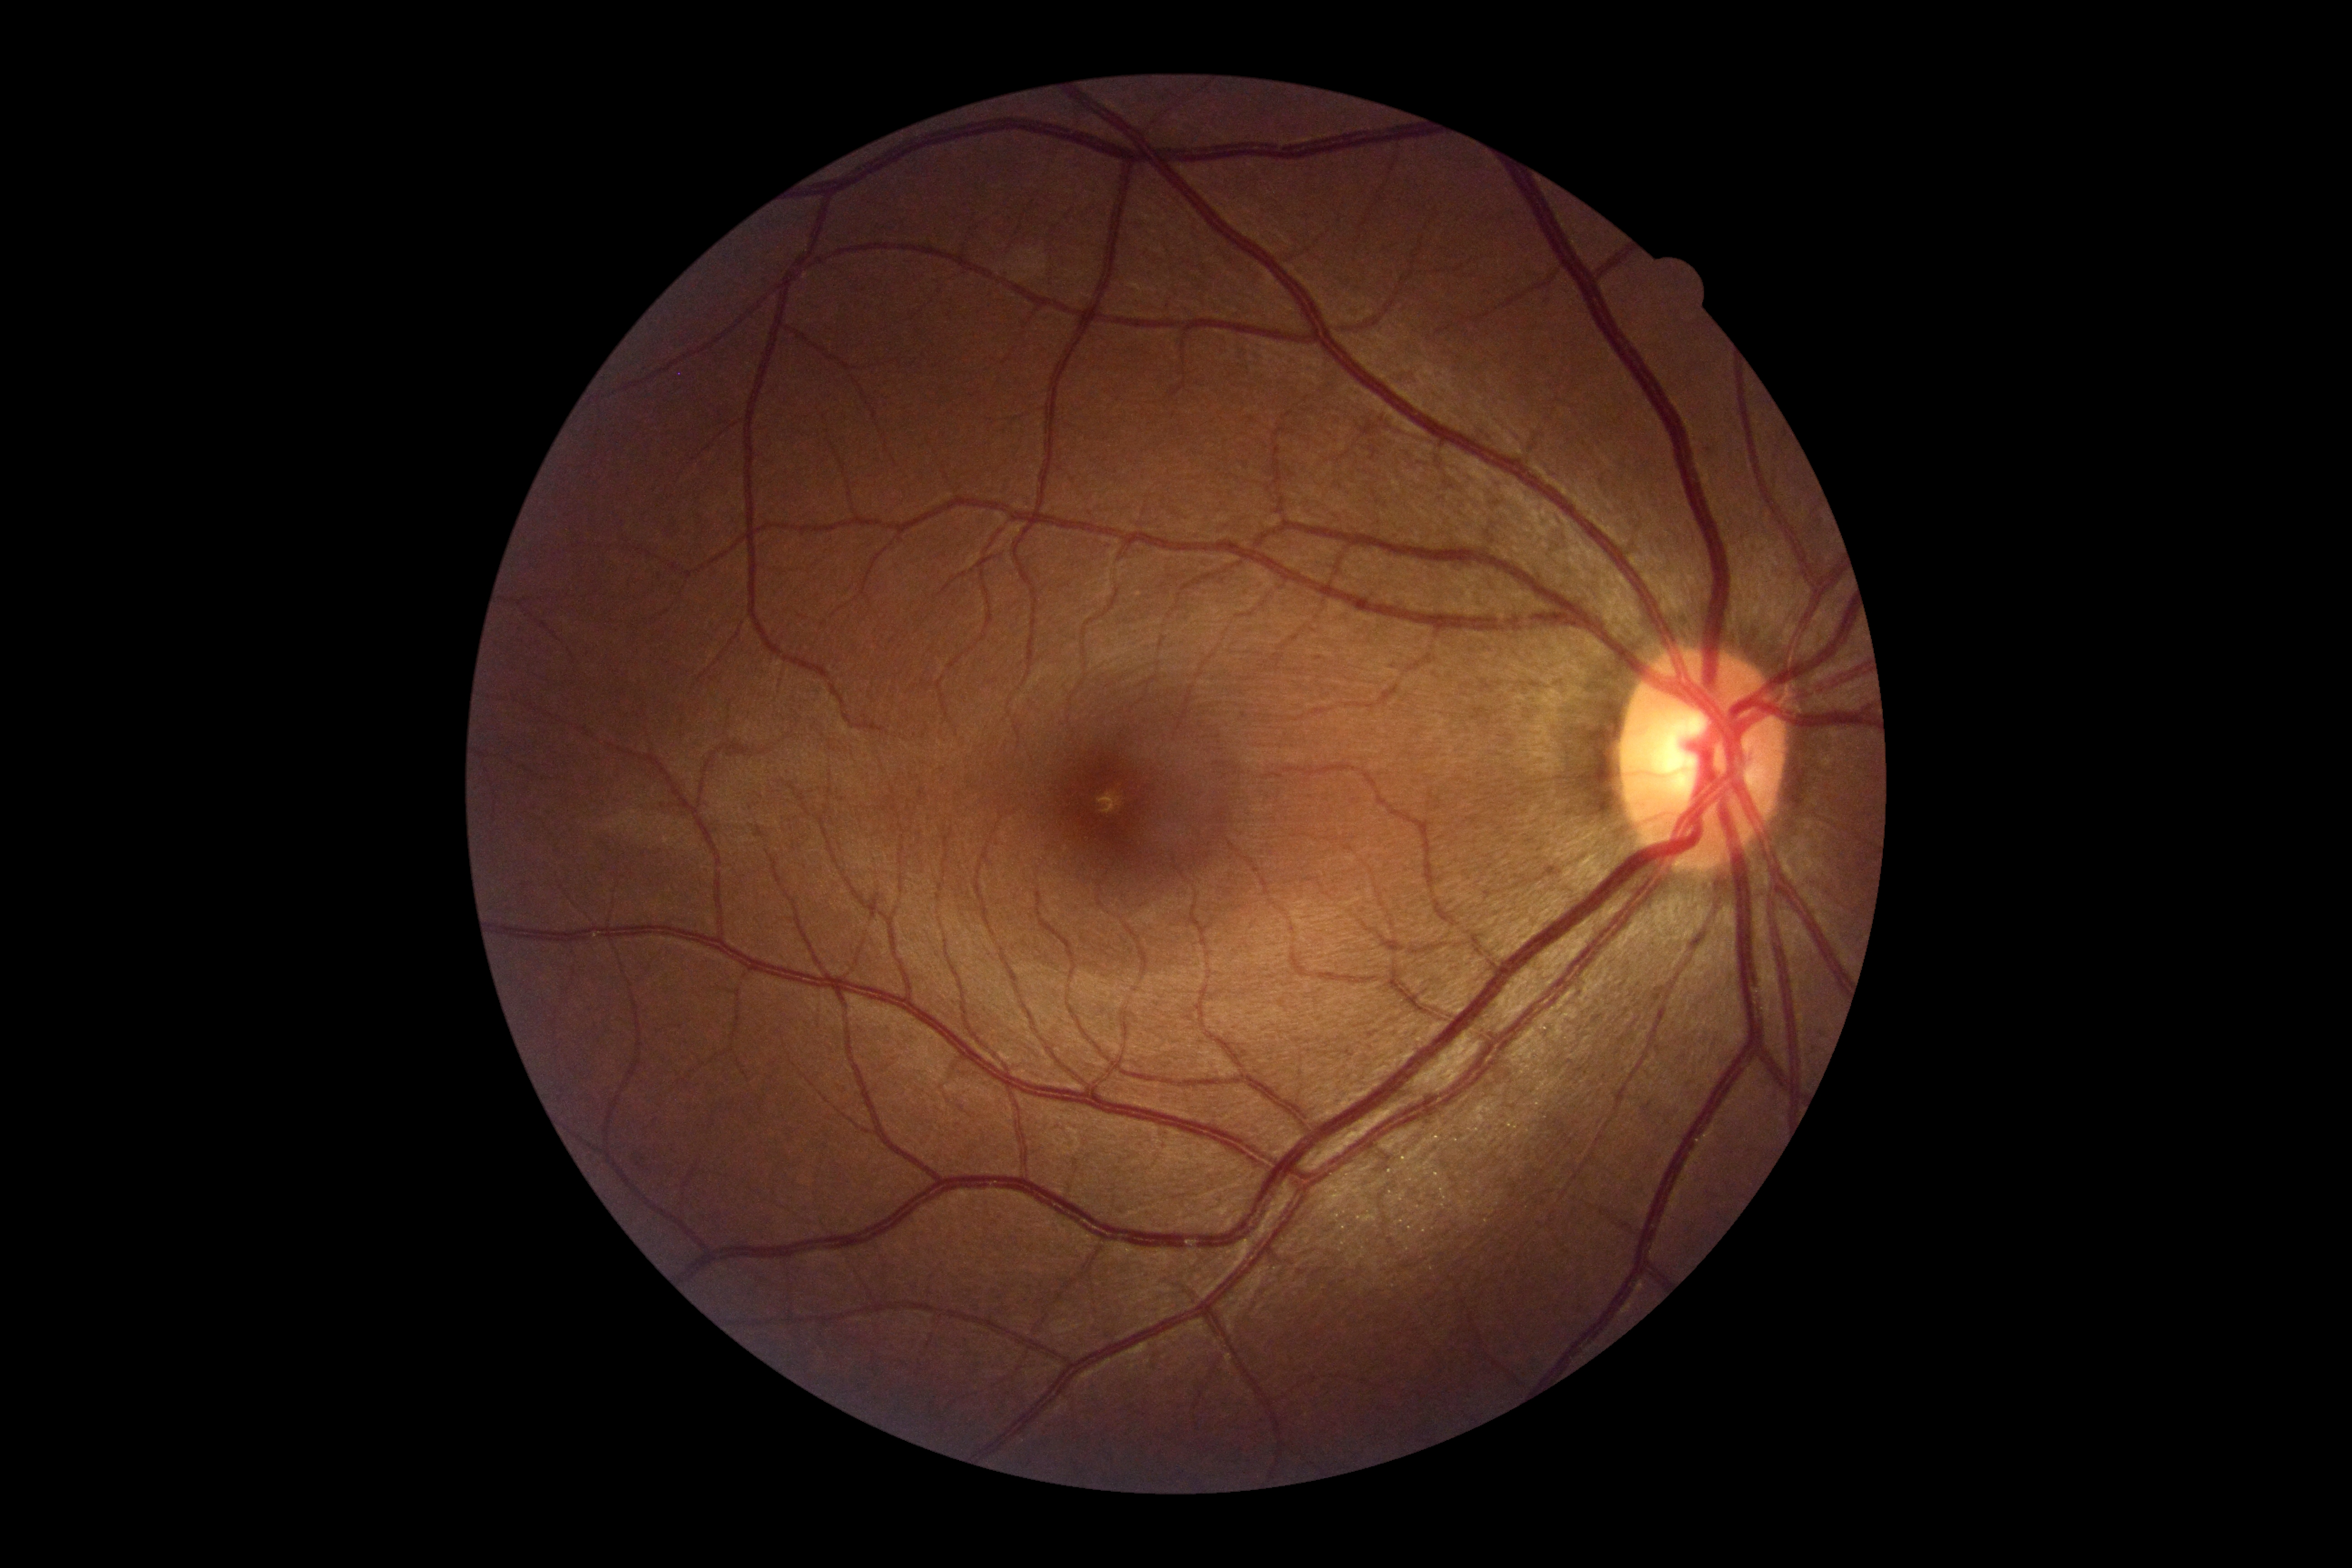 DR impression@no signs of DR; retinopathy@0.